Camera: Remidio Fundus on Phone (FOP) camera, 1659 x 2212 pixels — 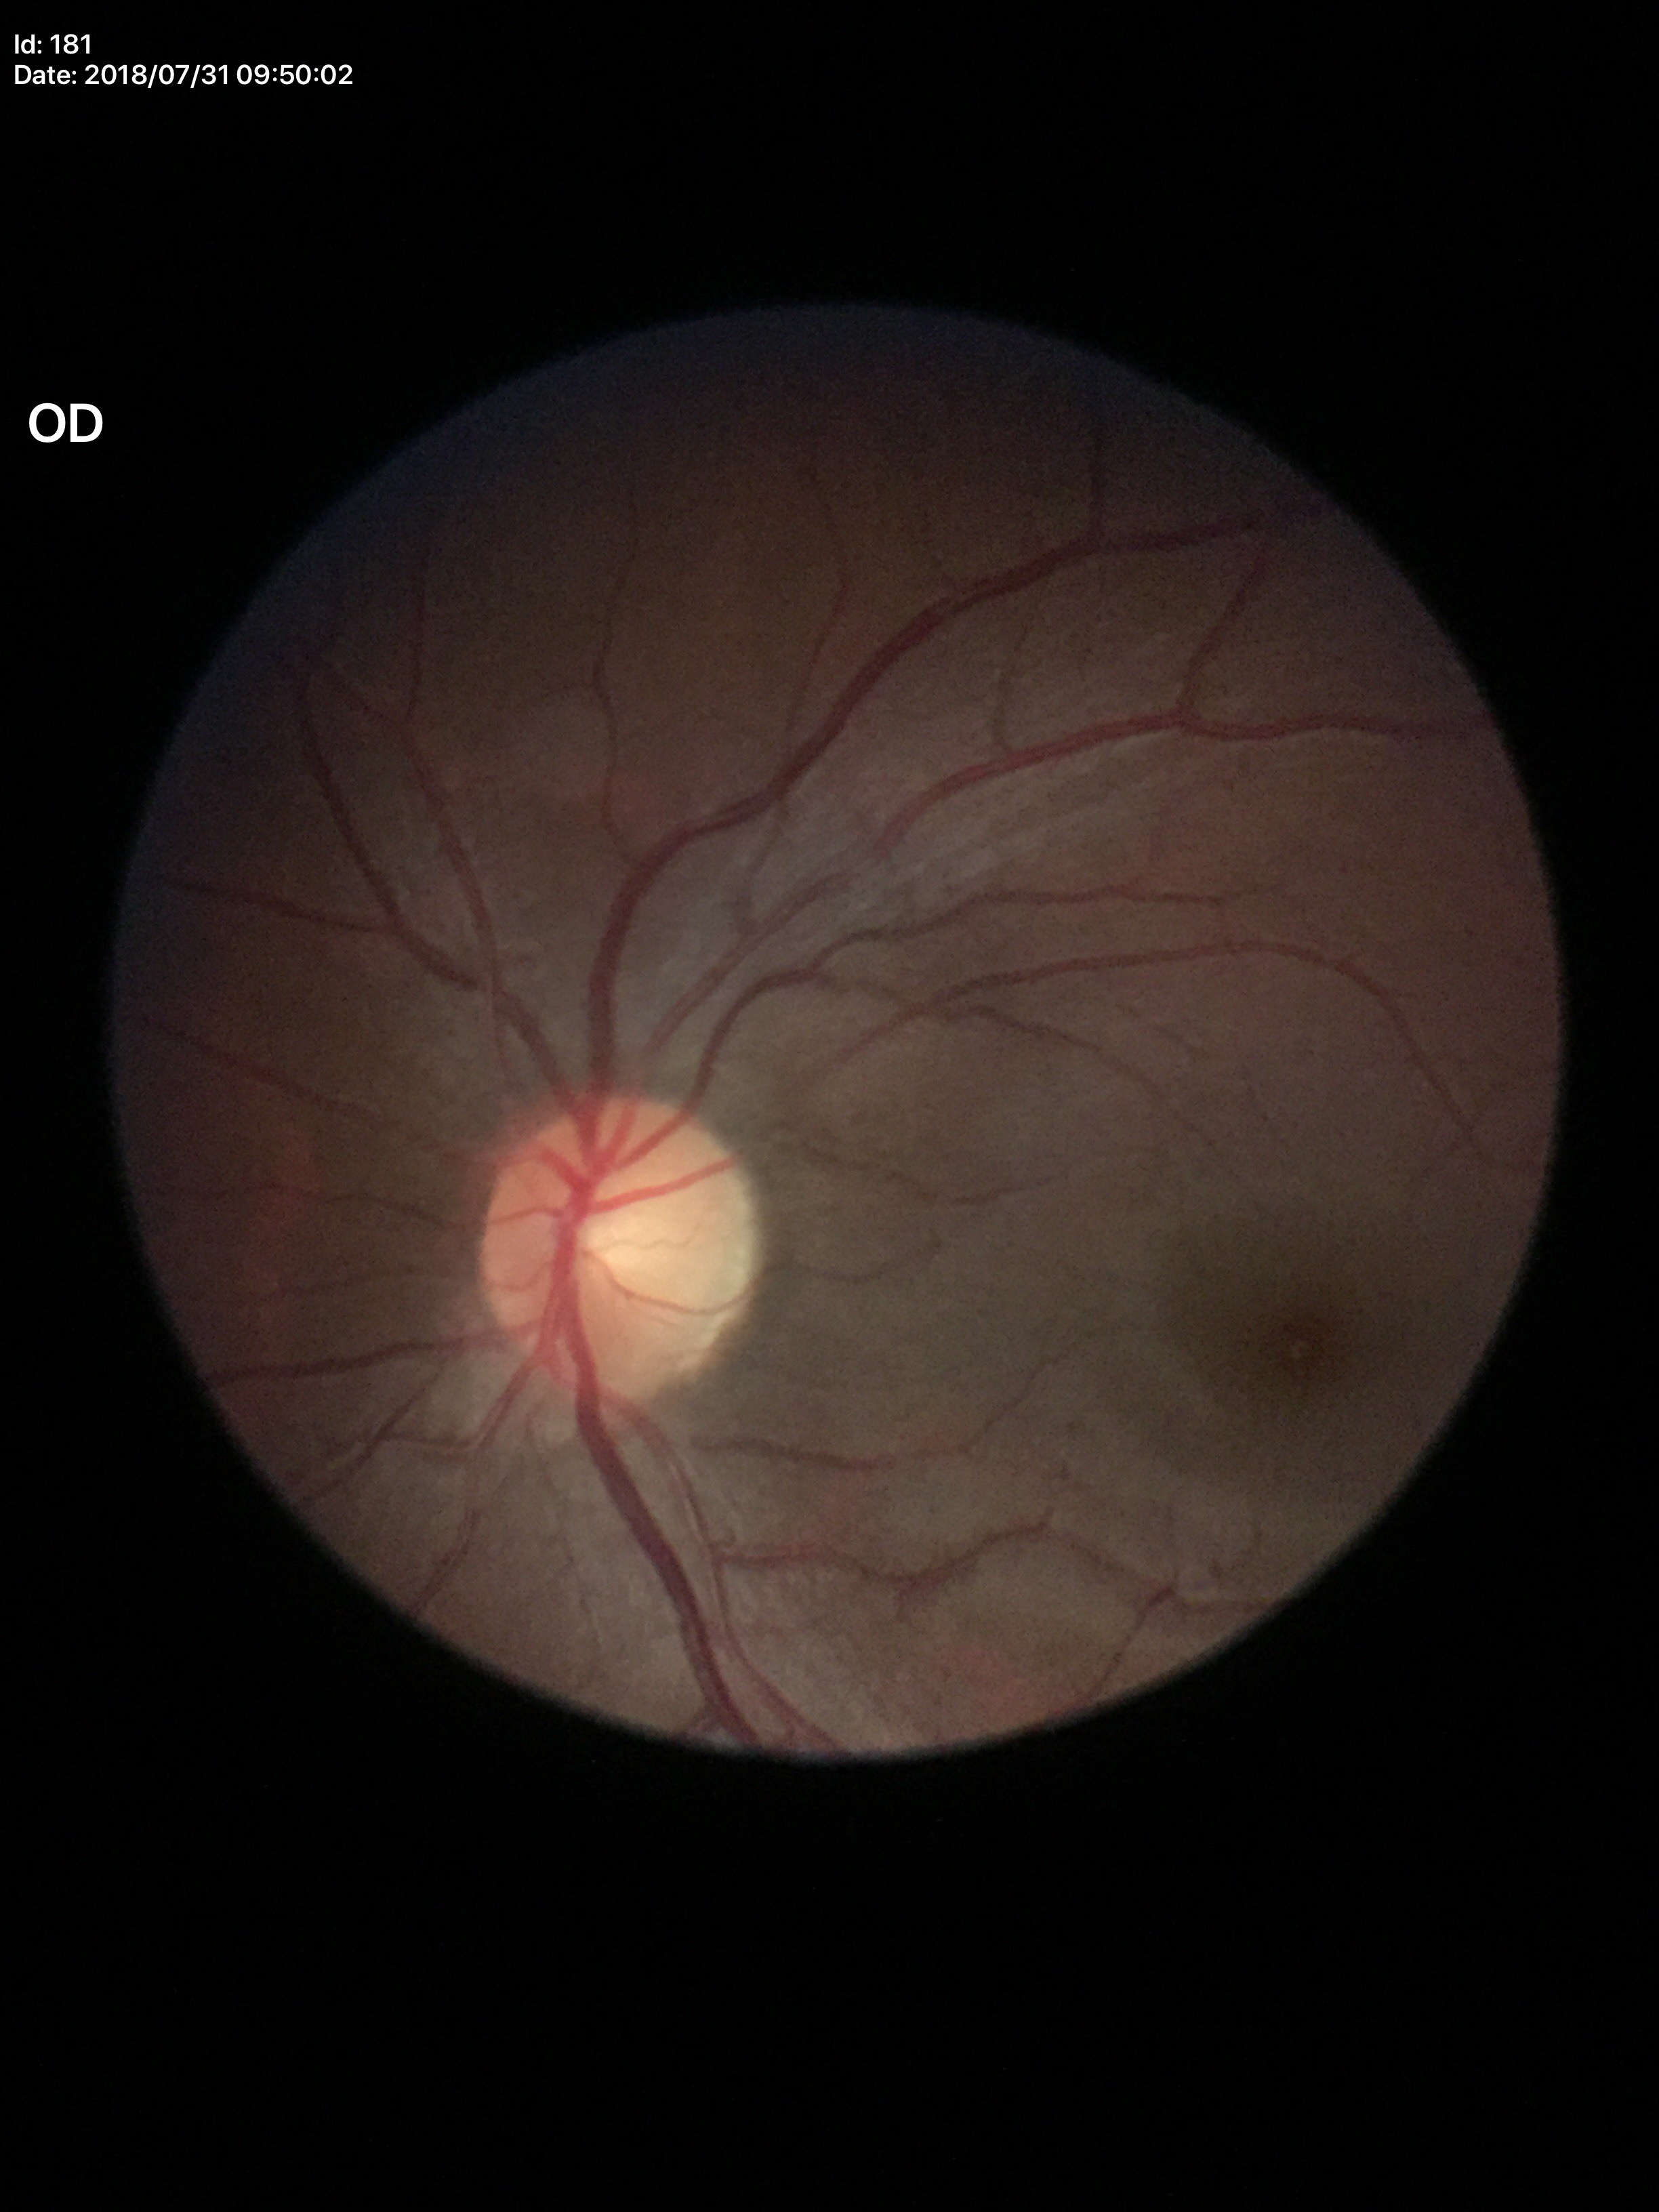

Glaucoma assessment: not suspect (one of five ophthalmologists flagged glaucoma suspect).
Vertical cup-disc ratio (VCDR) of 0.50.